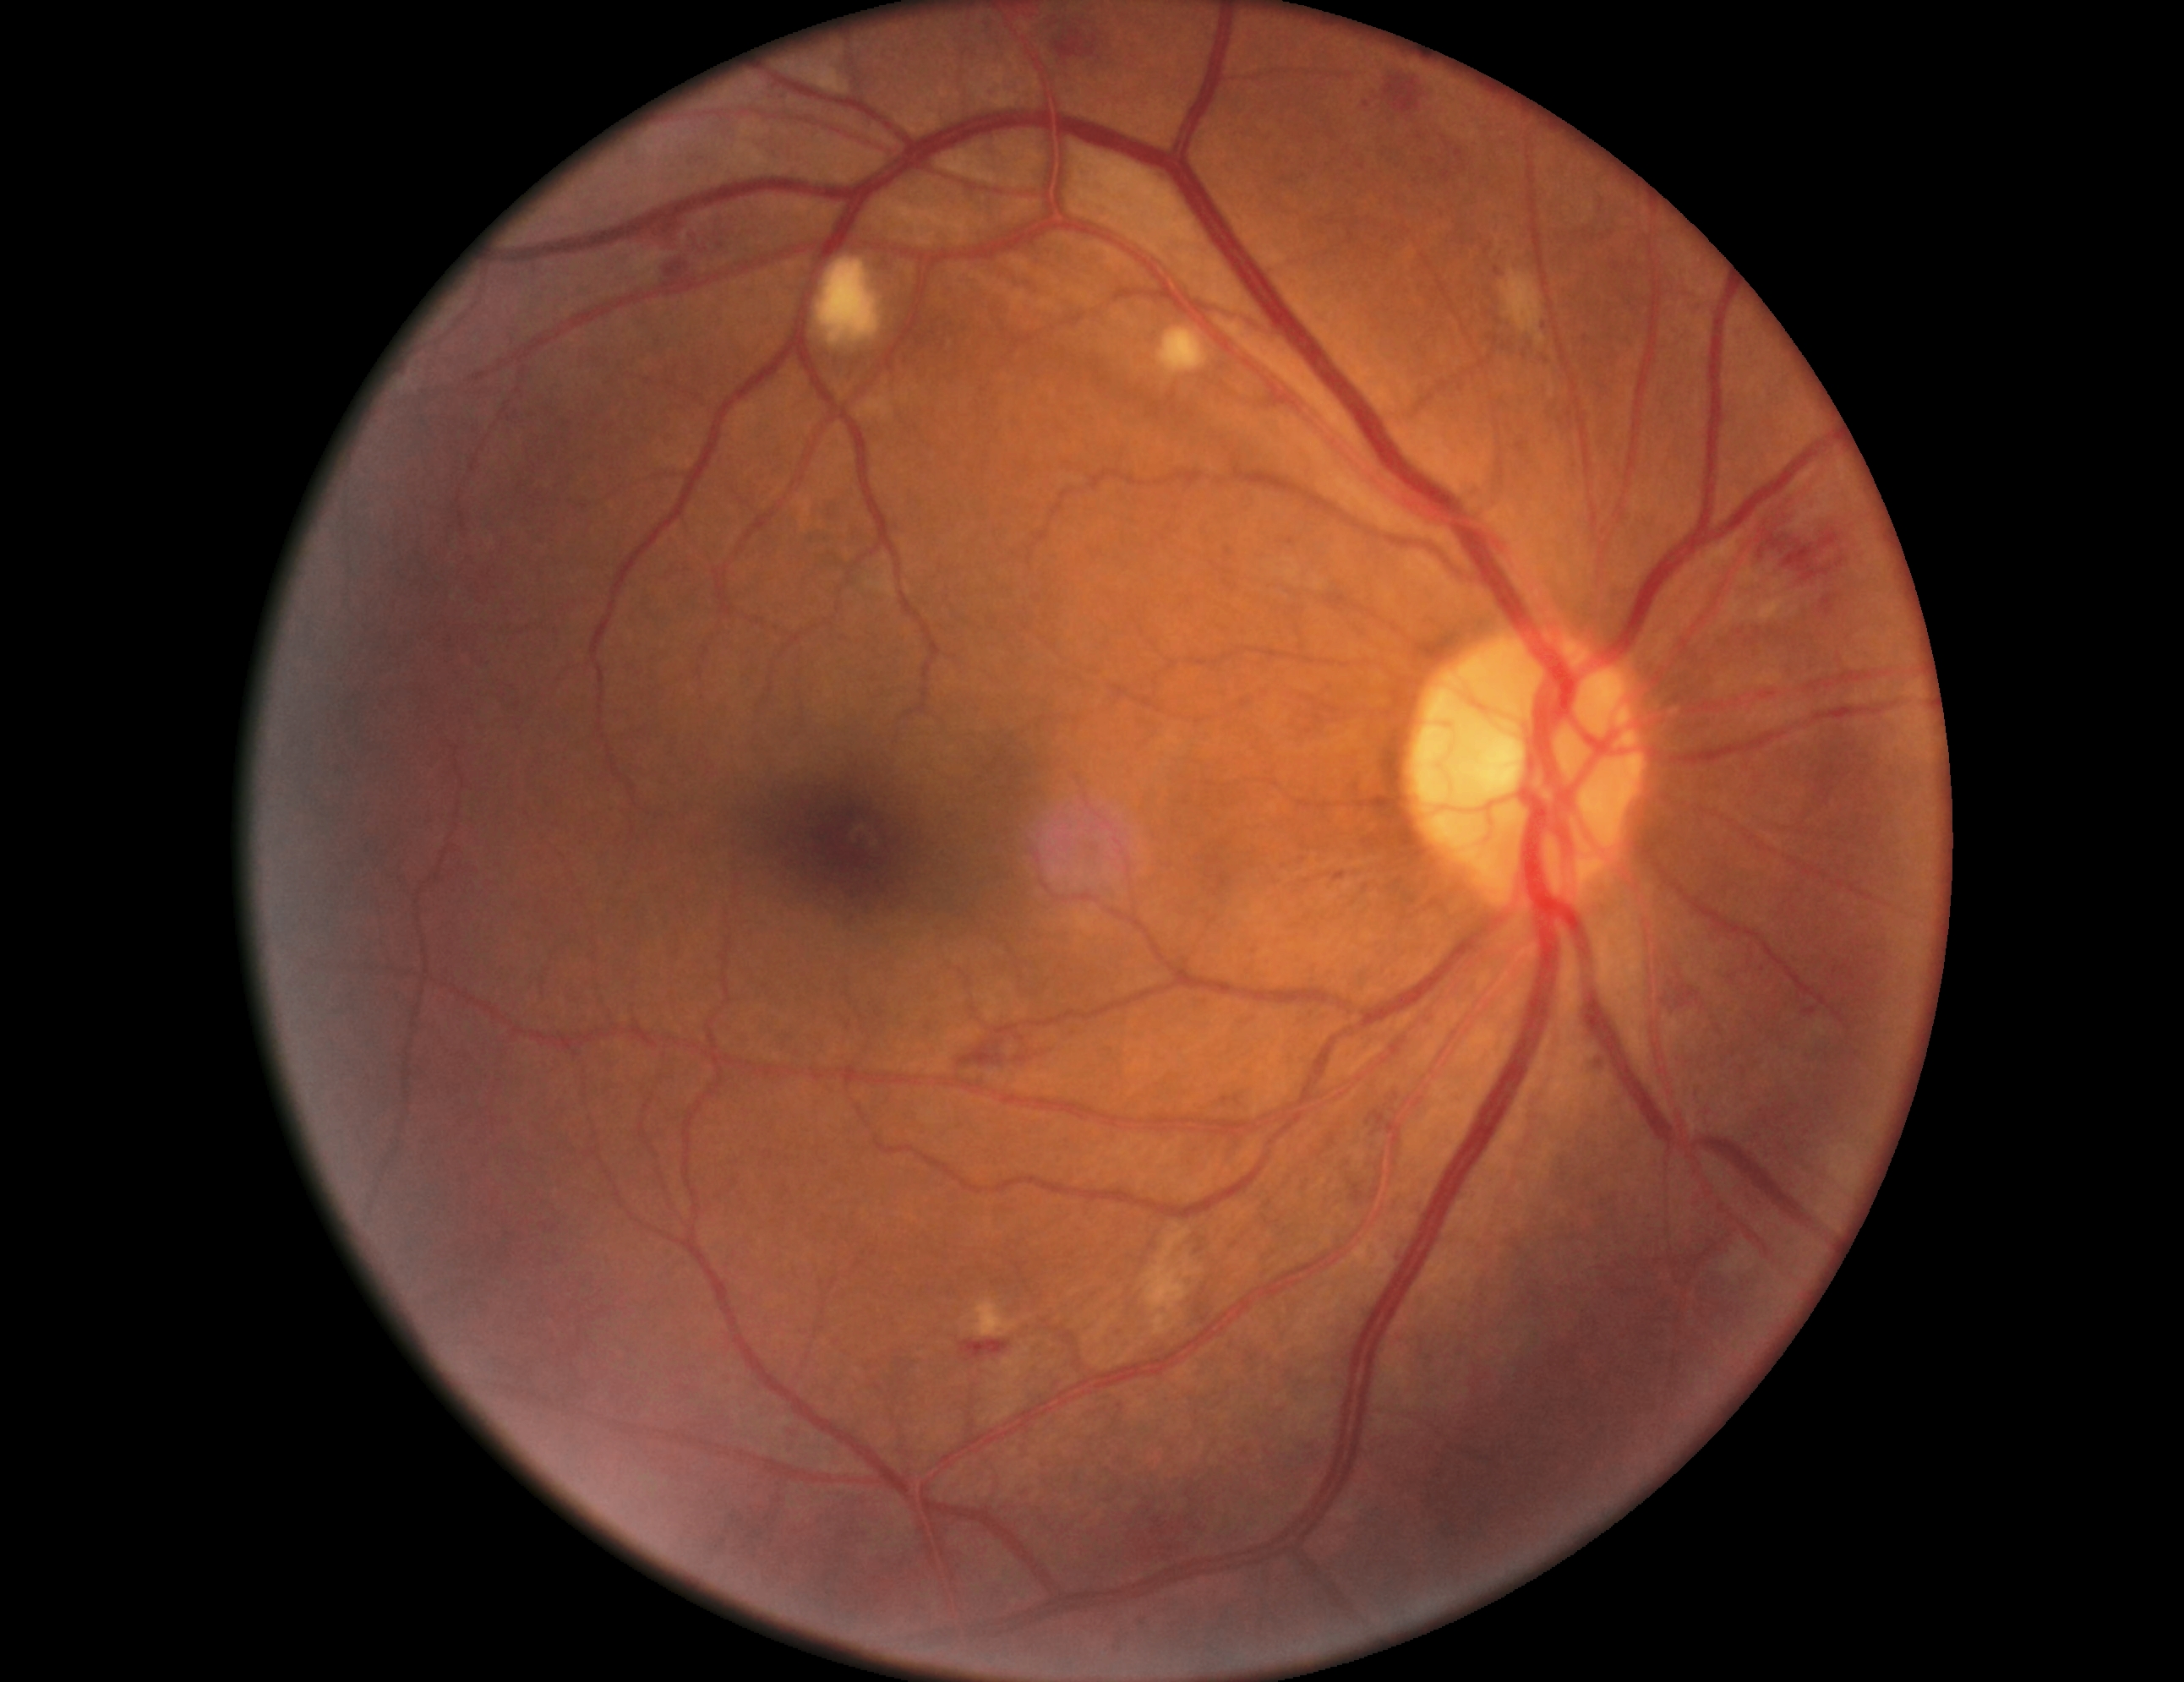 DR: grade 2 (moderate NPDR). Disease class: non-proliferative diabetic retinopathy.